Diabetic retinopathy graded by the modified Davis classification · acquired with a NIDEK AFC-230 · 45 degree fundus photograph.
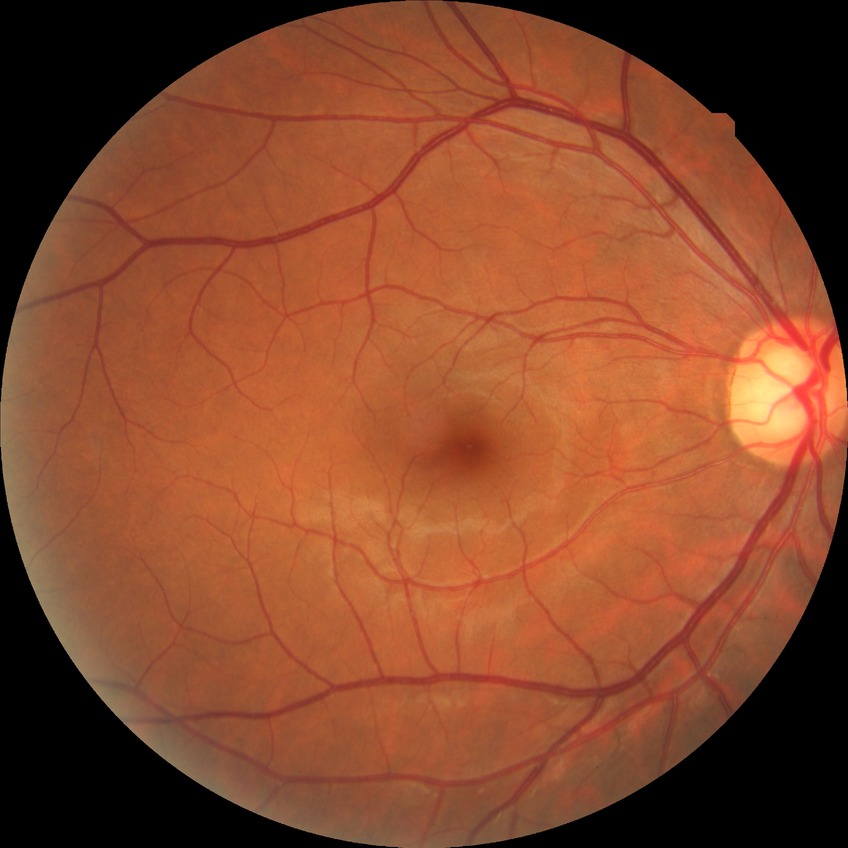
Diabetic retinopathy severity: no diabetic retinopathy.